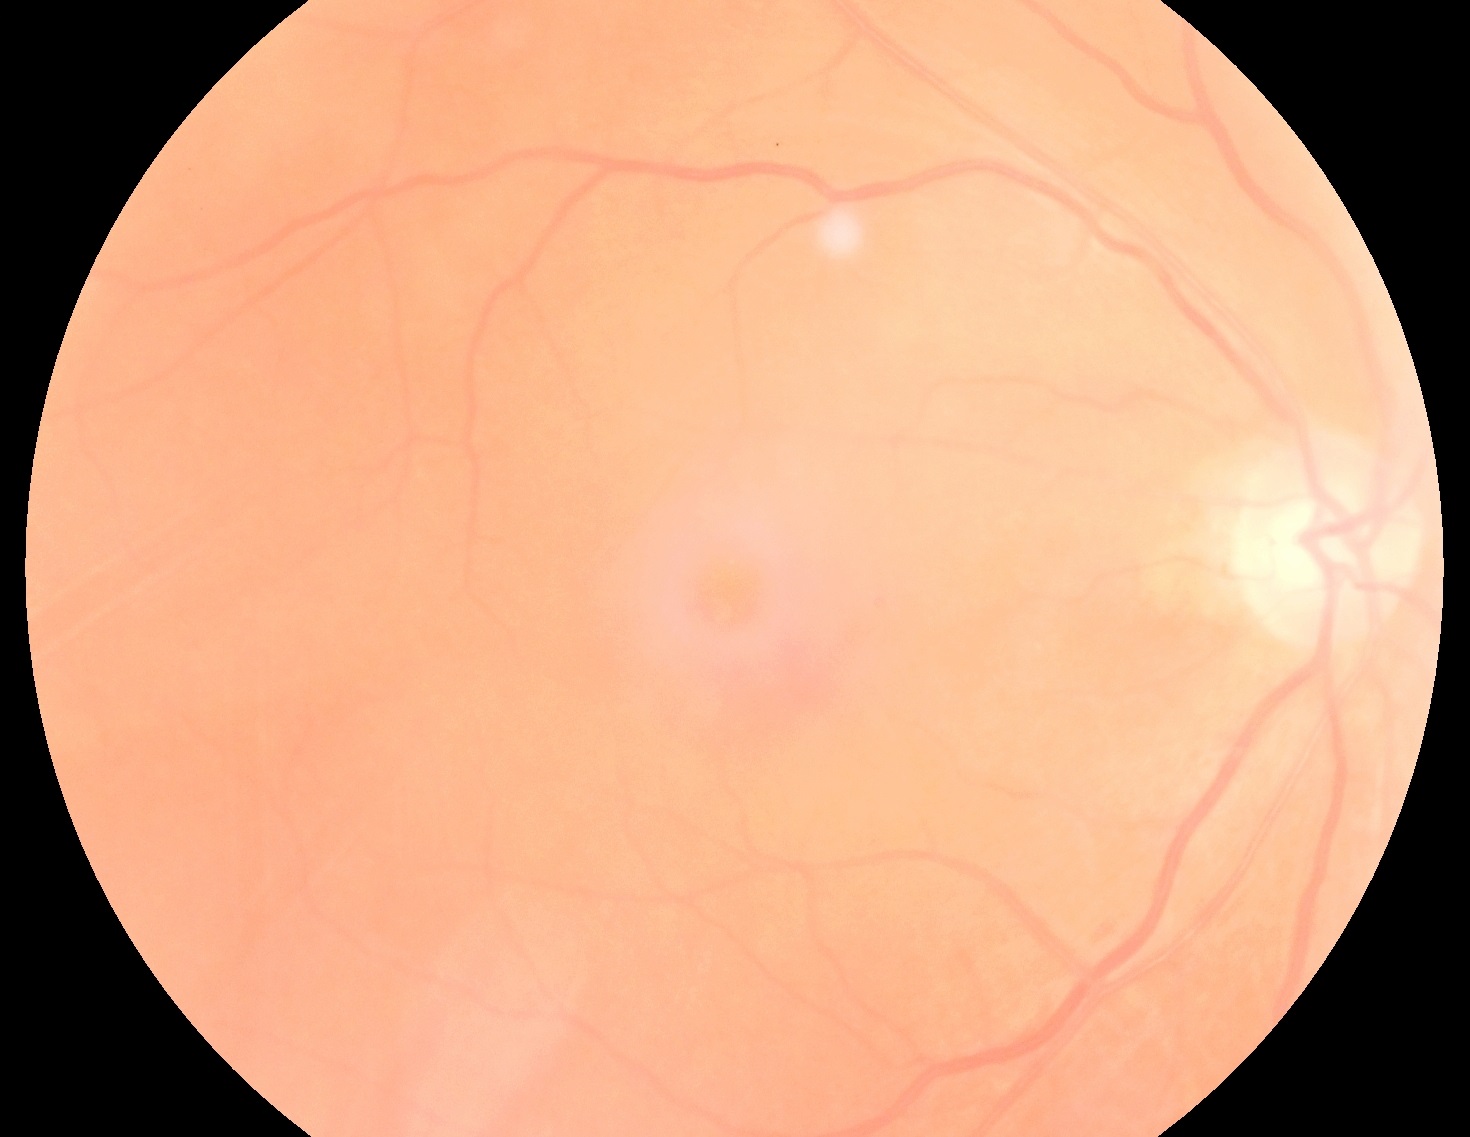 DR grade is 1/4 — presence of microaneurysms only.